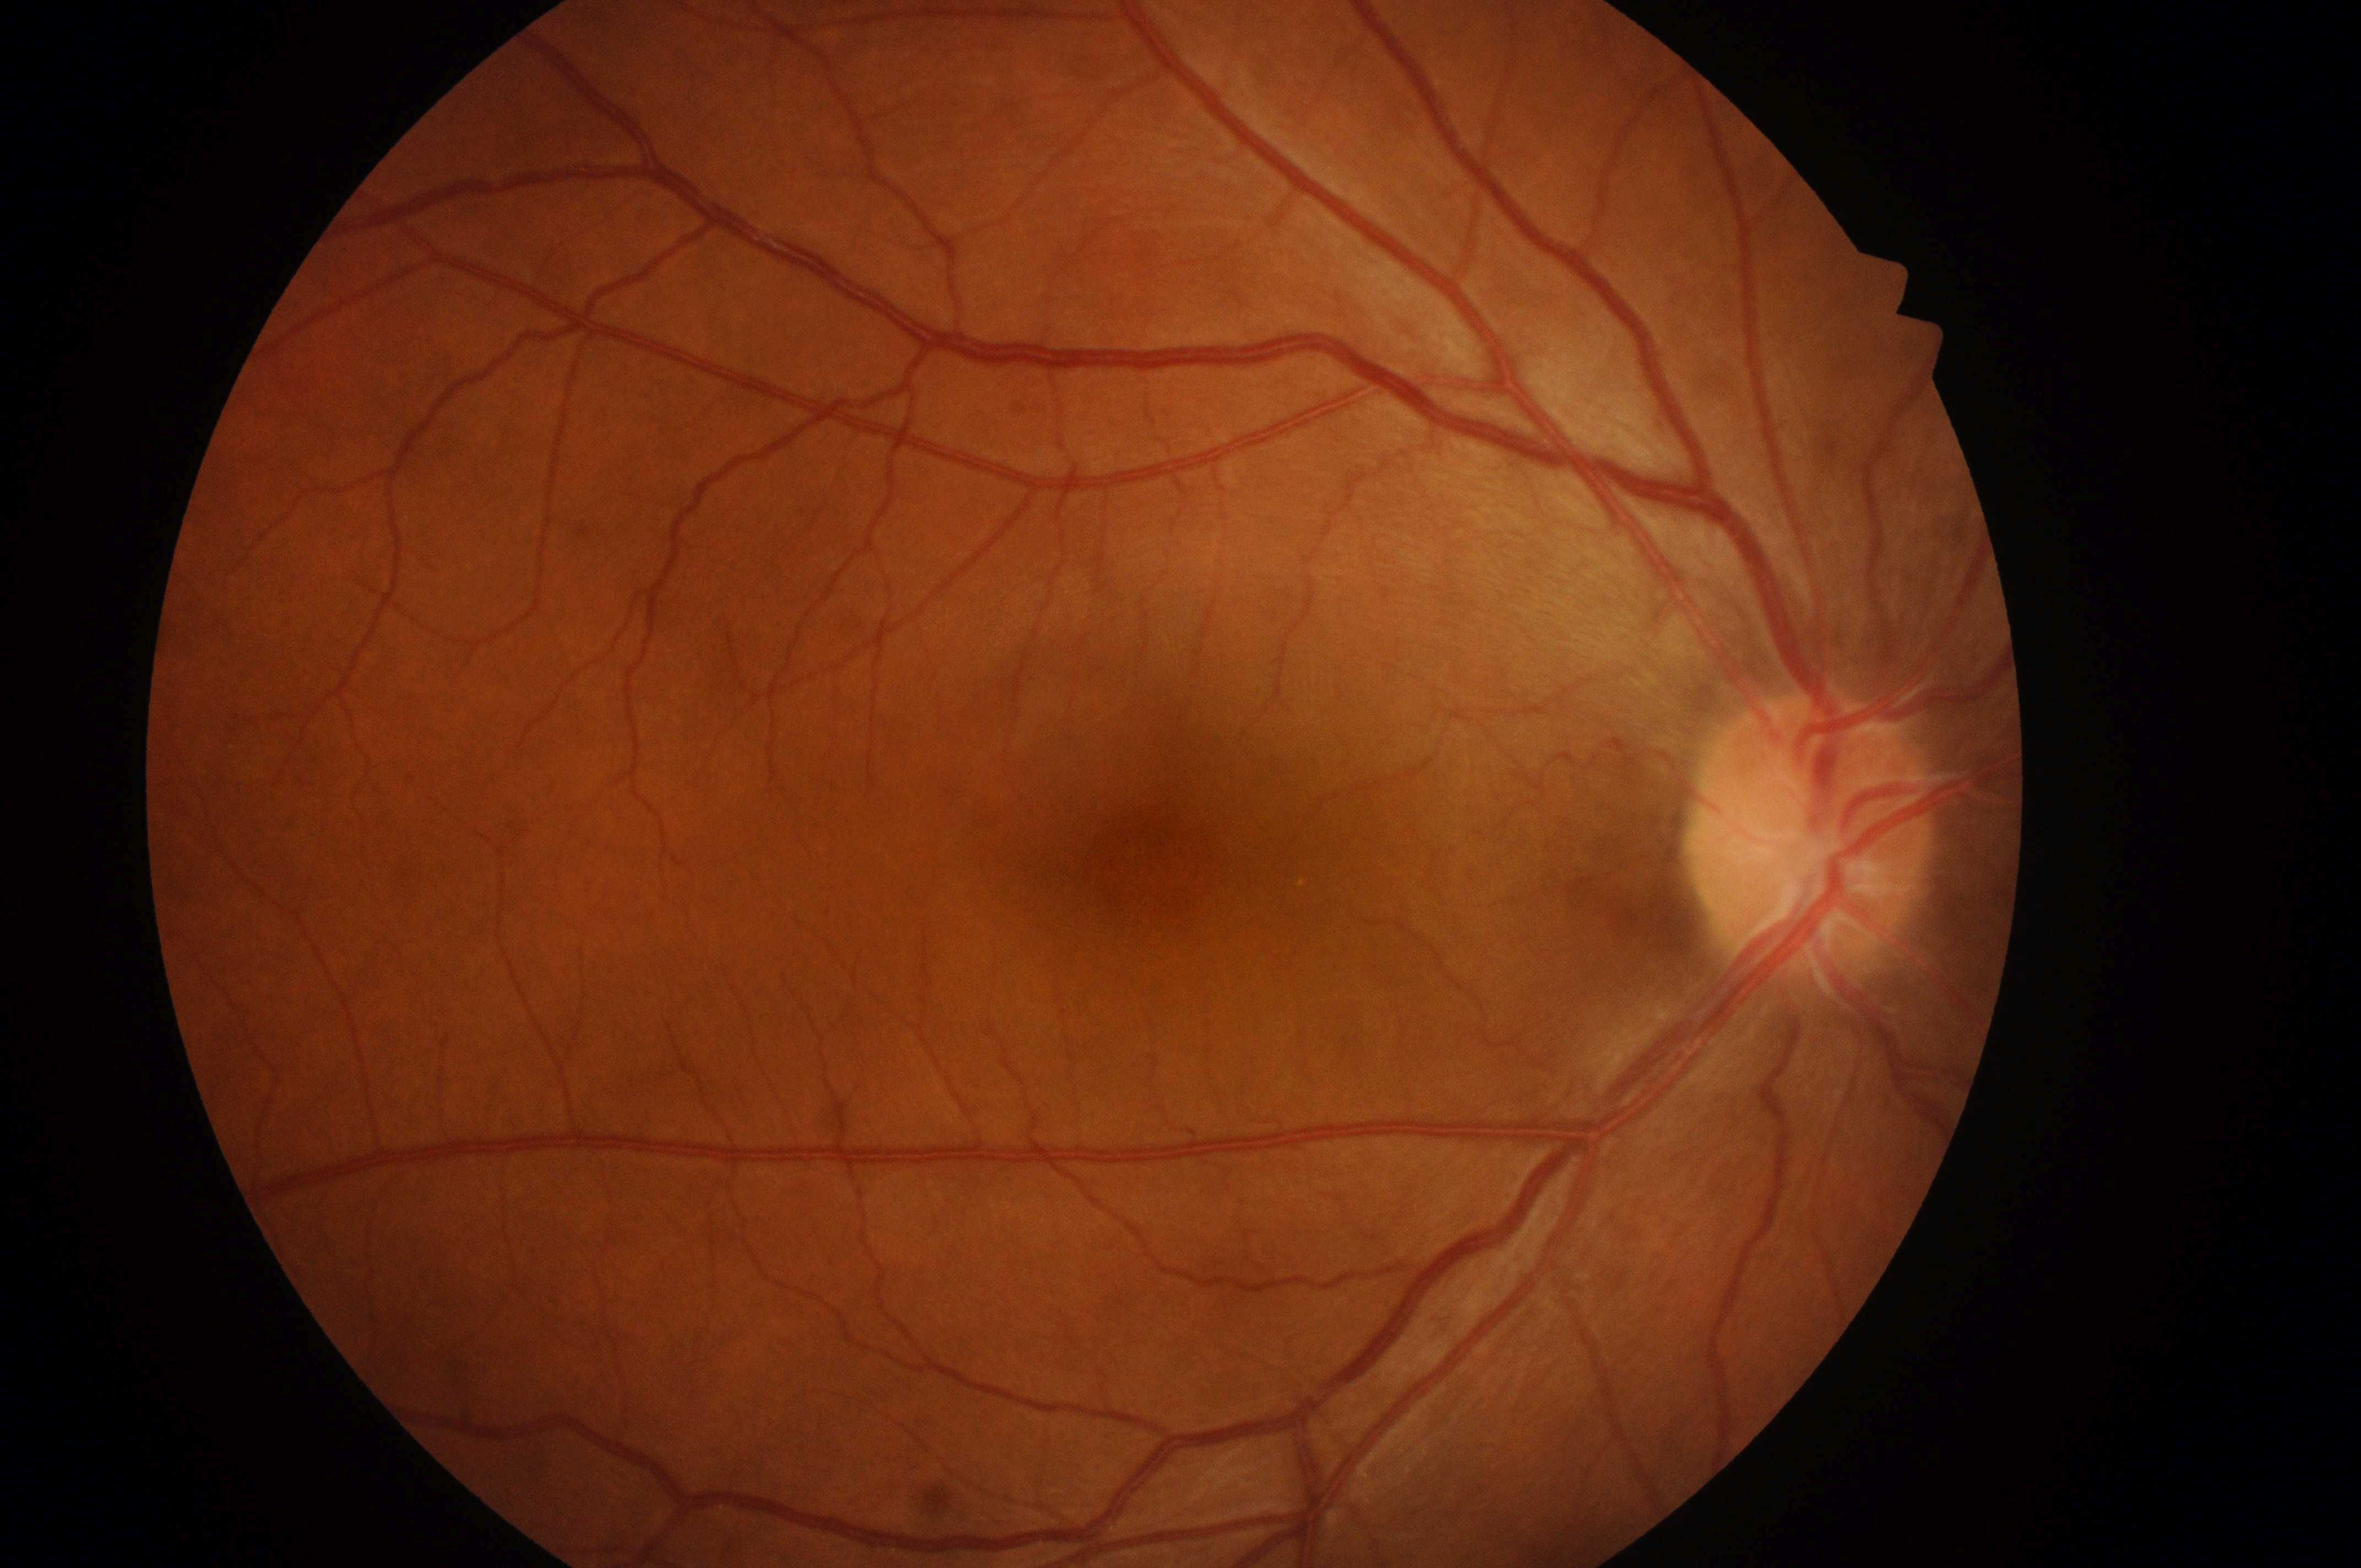

diabetic retinopathy grade: 0 (no apparent retinopathy) | risk of macular edema: no risk (grade 0) | No apparent diabetic retinopathy or macular edema | fovea center: (1153,870) | optic nerve head: (1803,850) | right eye.